Modified Davis classification.
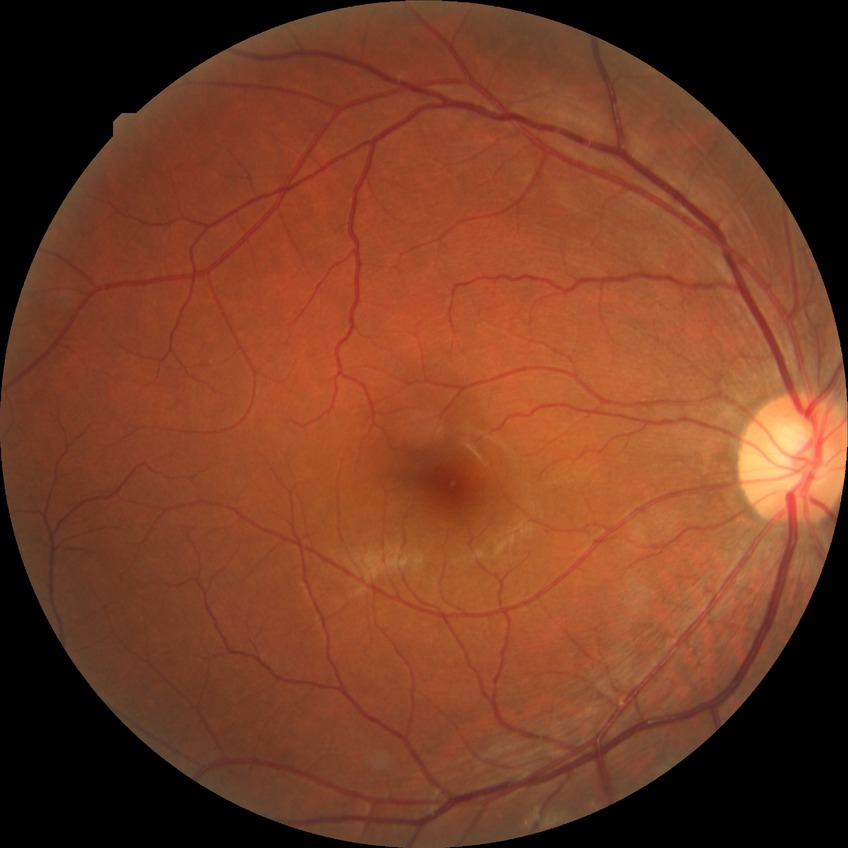 diabetic retinopathy severity=no diabetic retinopathy.